1240 x 1240 pixels · pediatric wide-field fundus photograph: 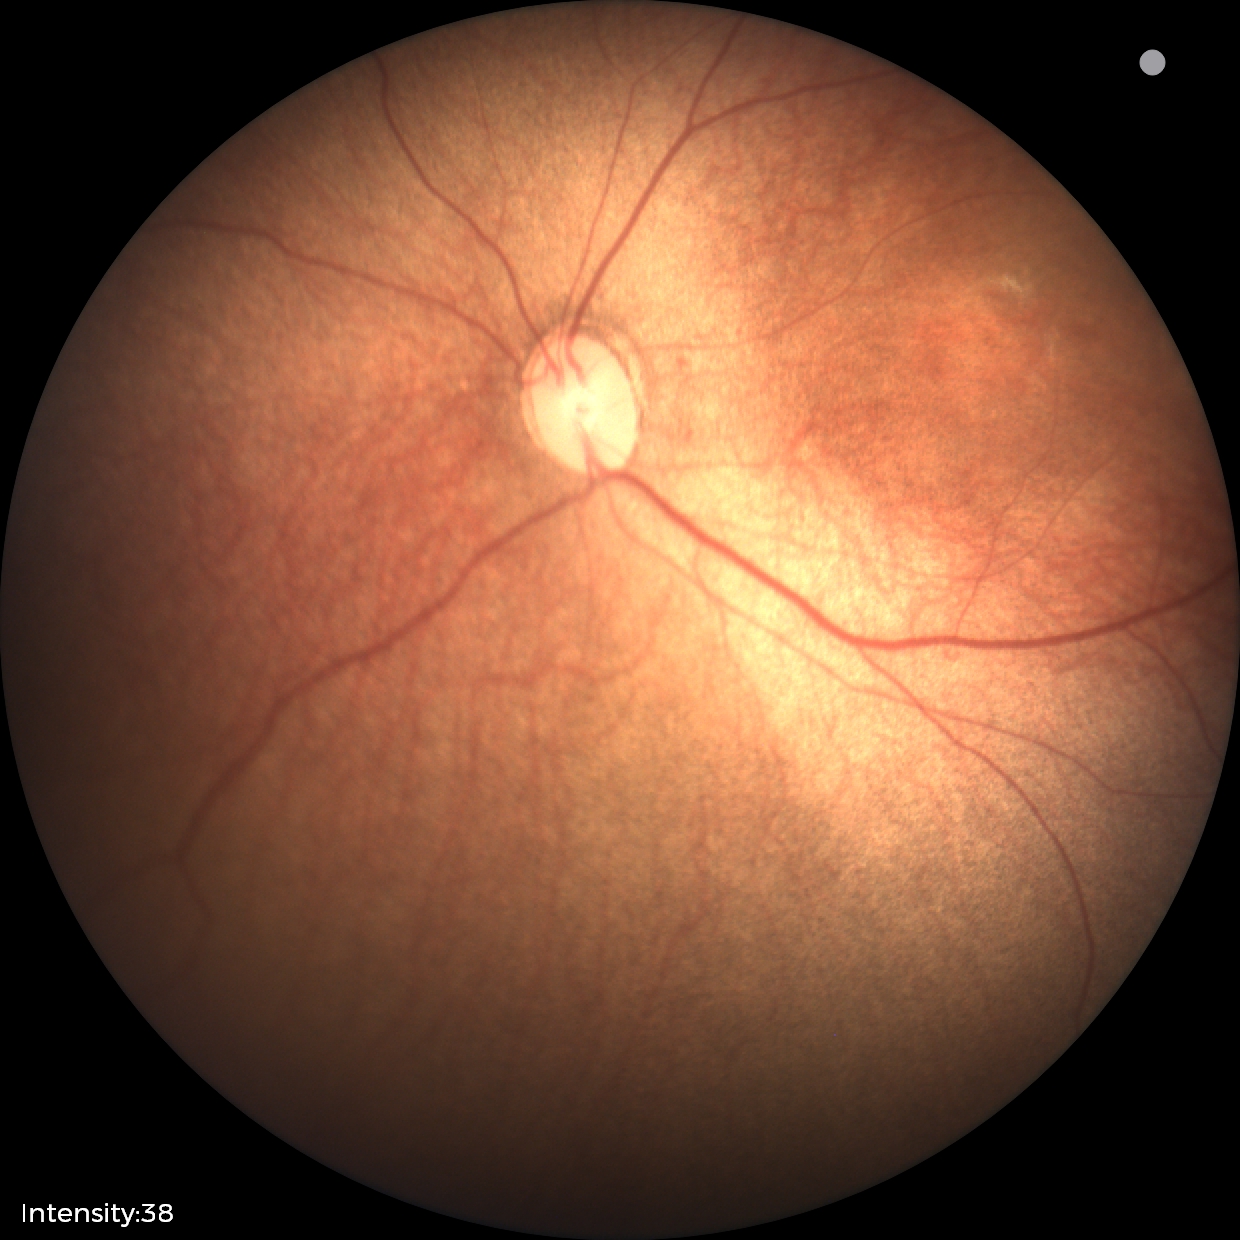 Examination diagnosed as status post retinopathy of prematurity — retinal appearance after treated retinopathy of prematurity.
No plus disease.